45-degree field of view; color fundus image; 2212x1659px:
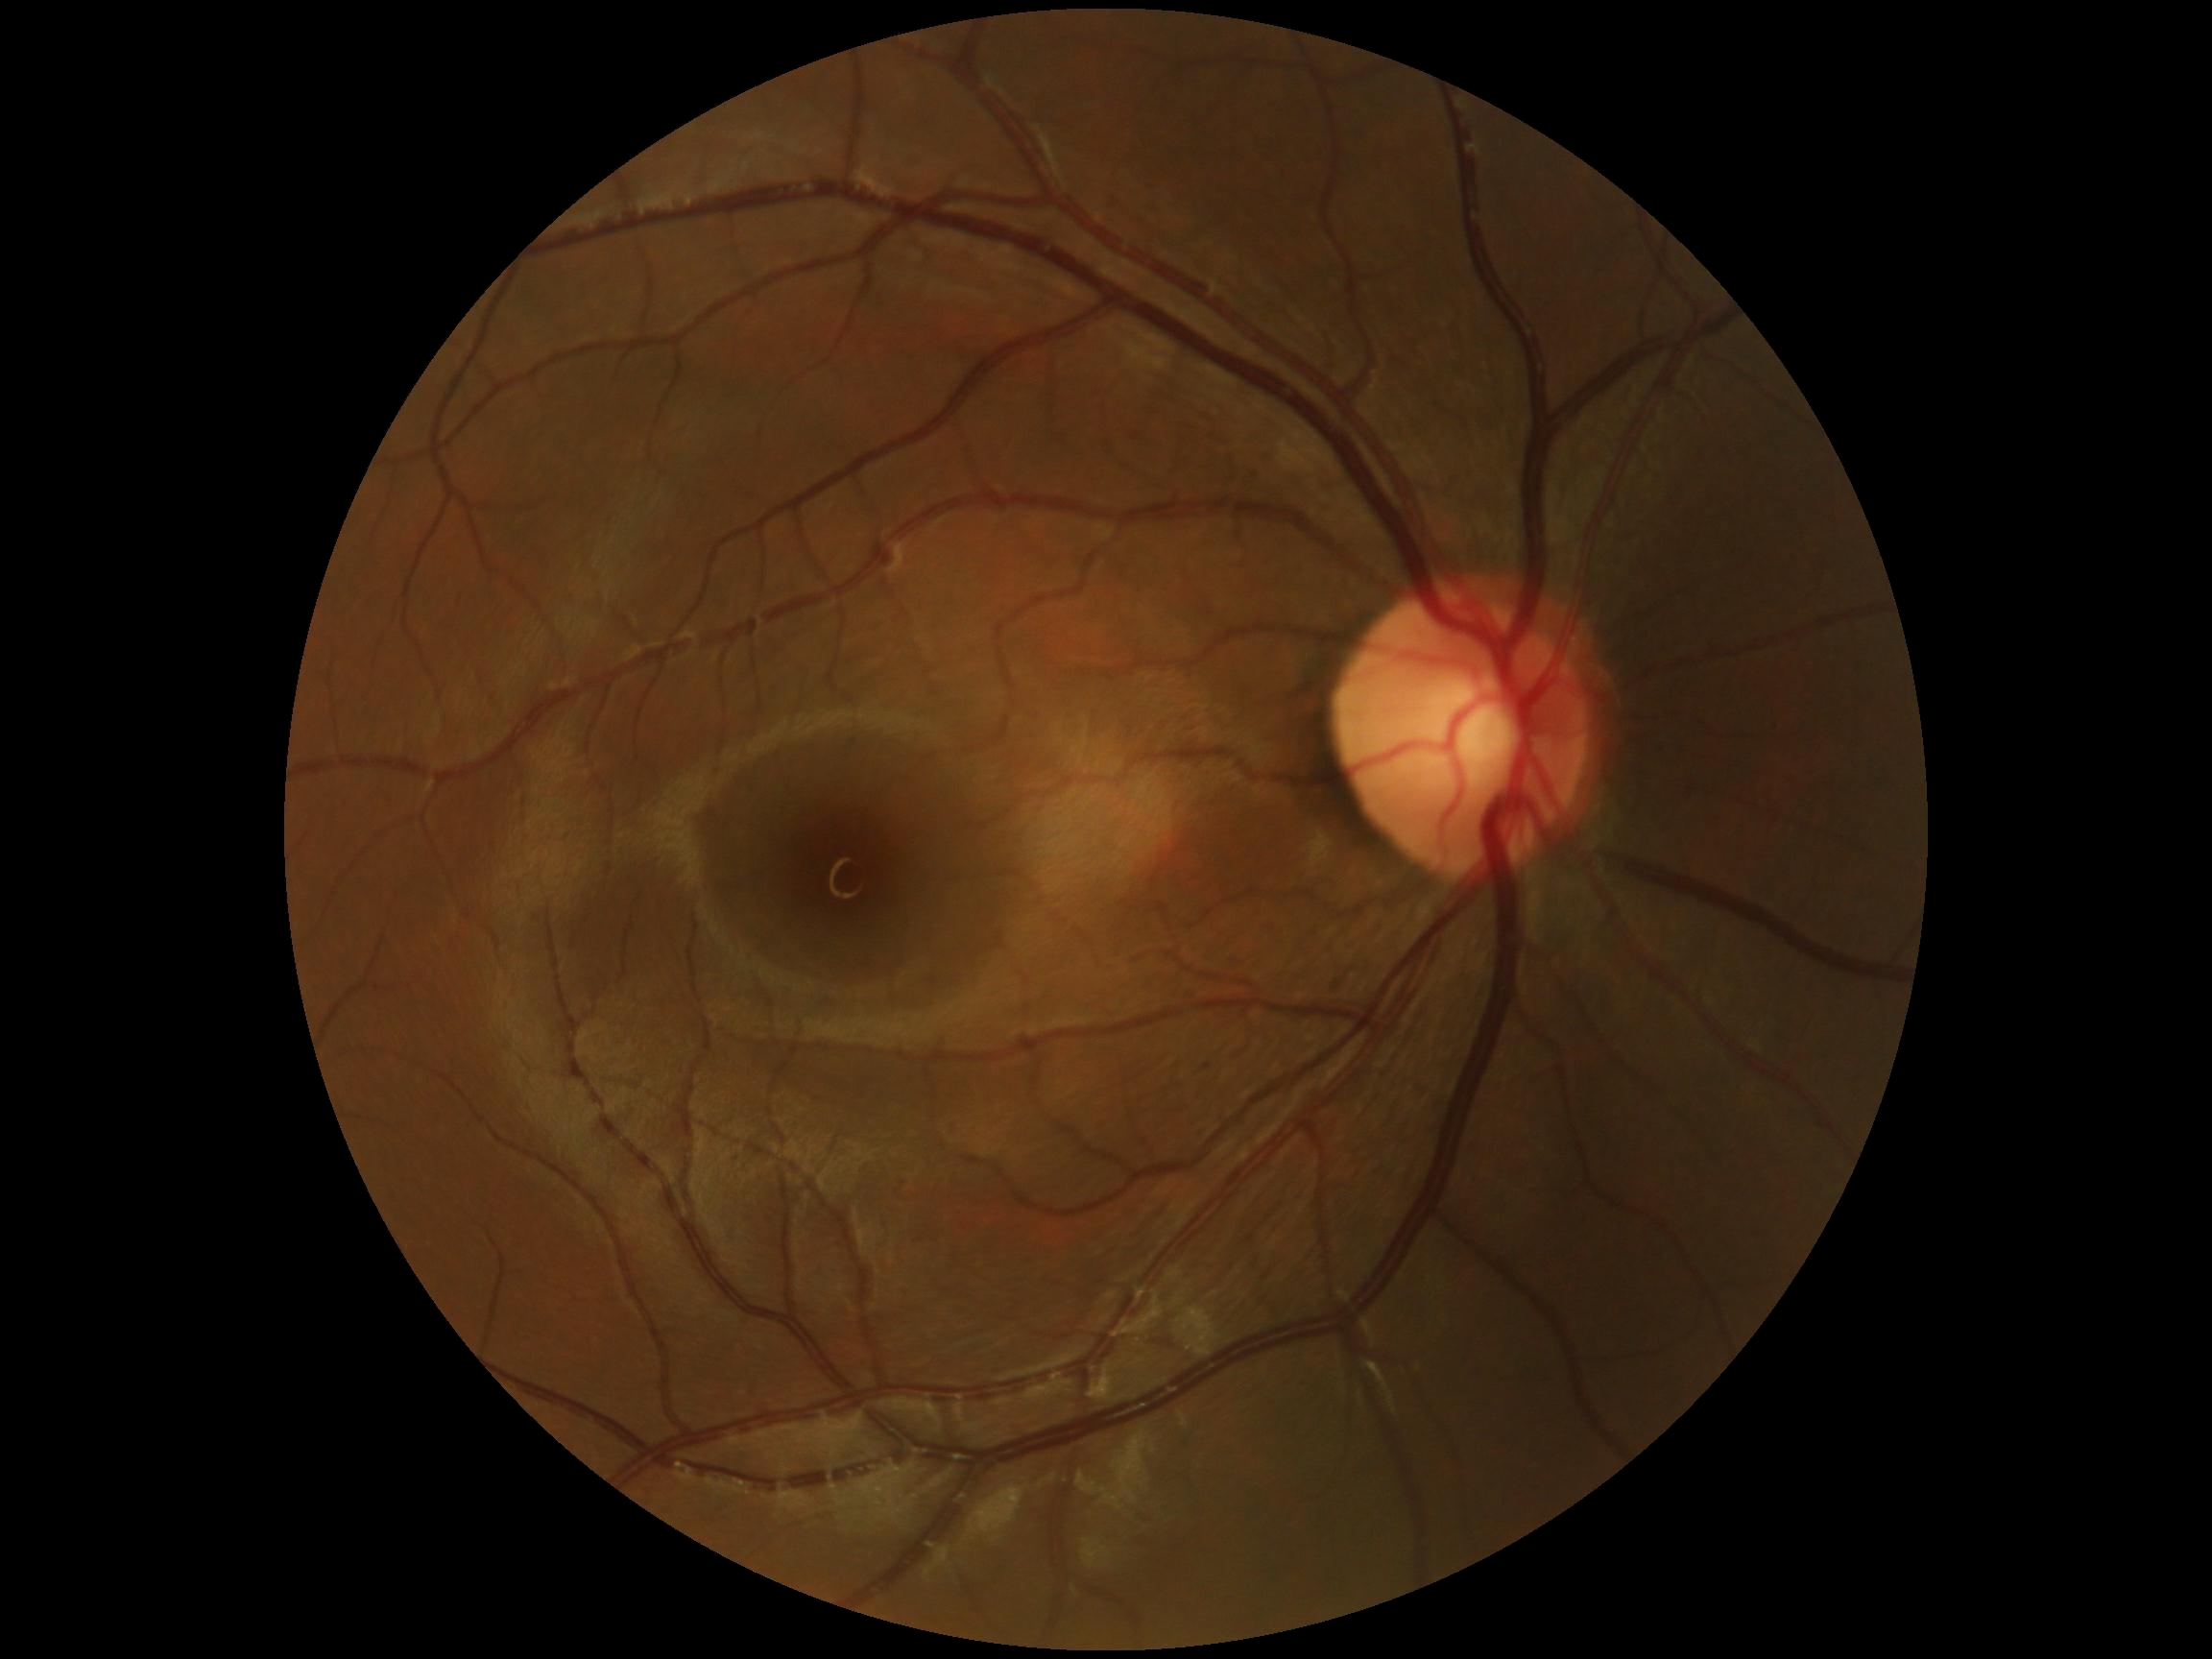

No diabetic retinal disease findings. Diabetic retinopathy severity: no apparent diabetic retinopathy (grade 0).